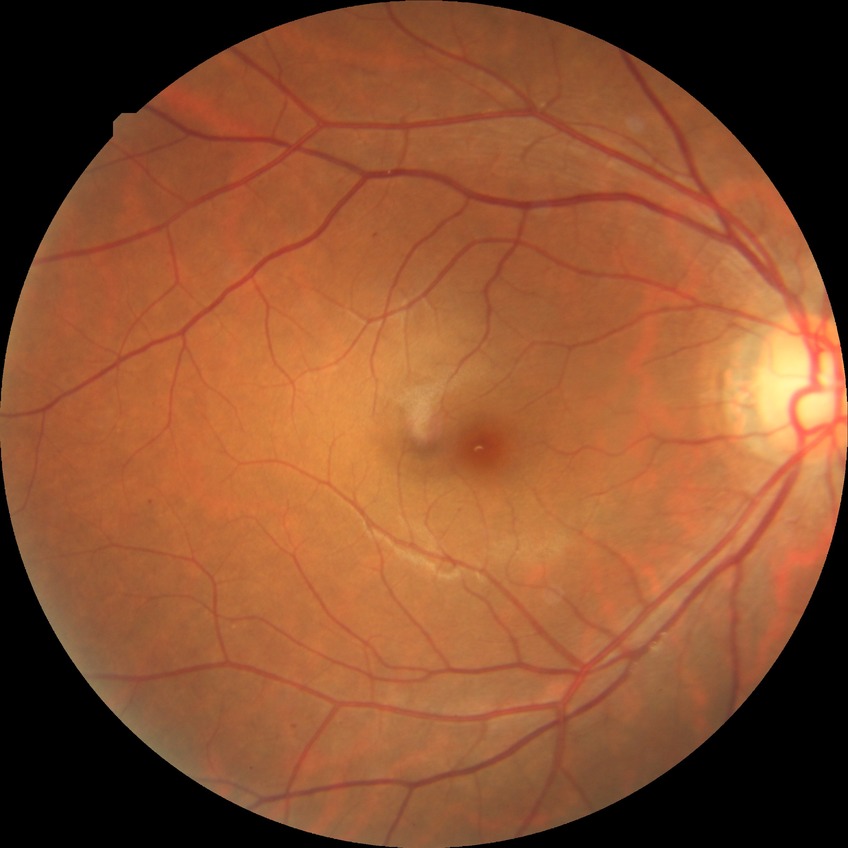
Assessment:
– diabetic retinopathy (DR): SDR (simple diabetic retinopathy)